Pediatric wide-field fundus photograph · captured with the Phoenix ICON (100° field of view):
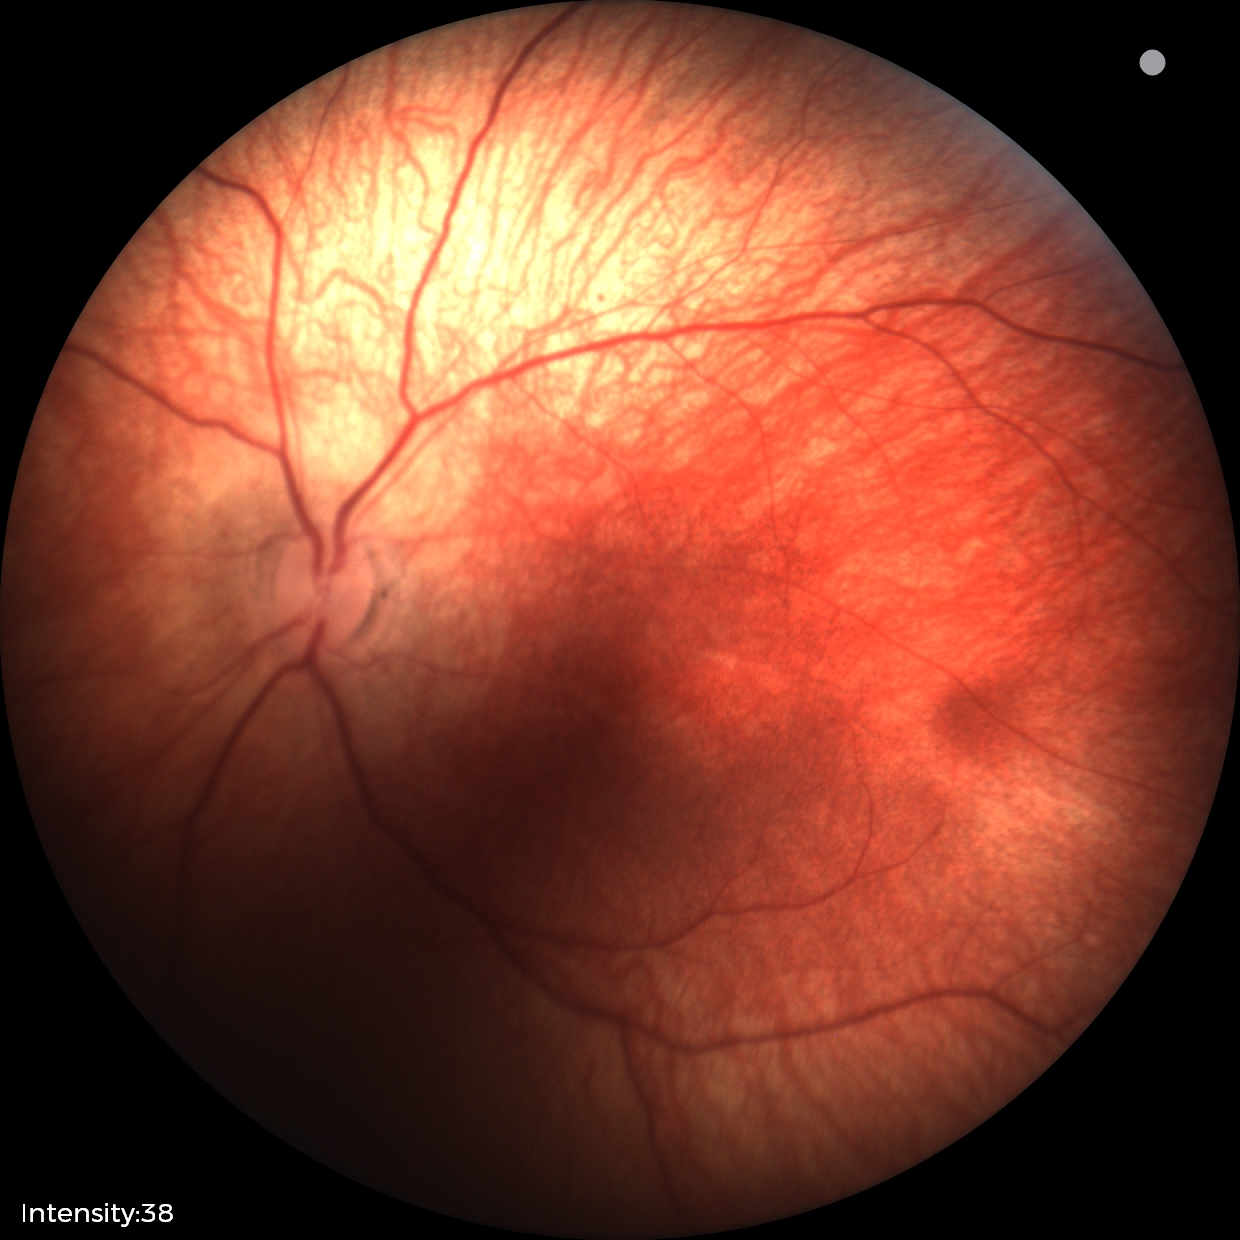
No retinal pathology identified on screening.